Acquired on the Natus RetCam Envision; pediatric wide-field fundus photograph: 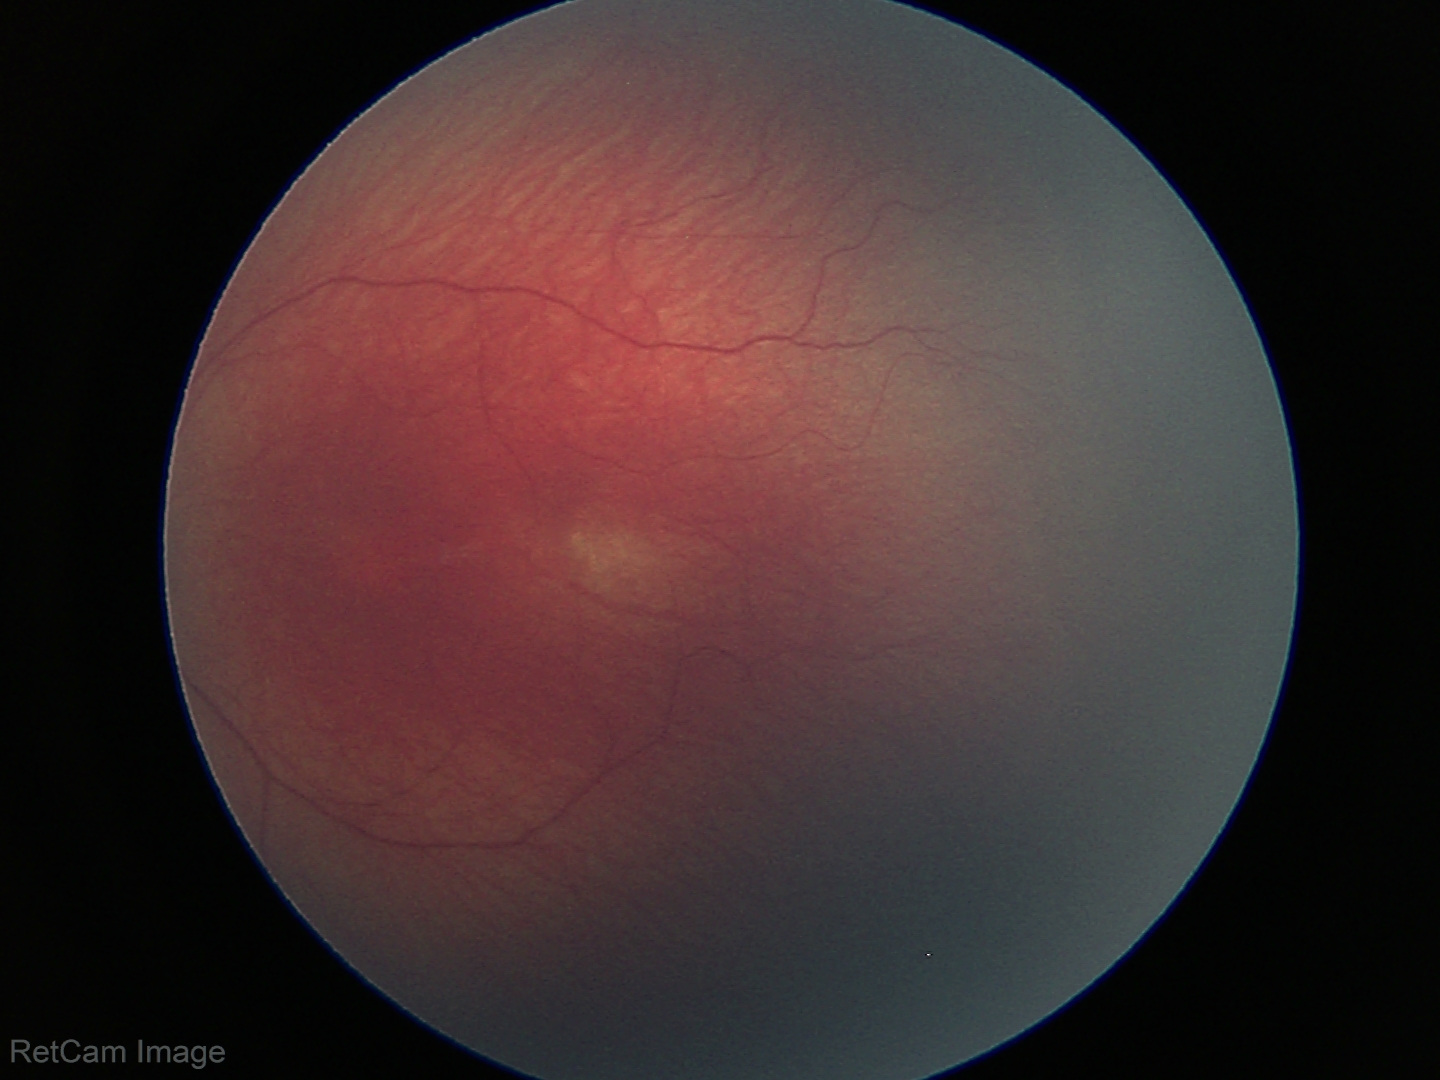
Diagnosis = ROP stage 1
plus form = absent